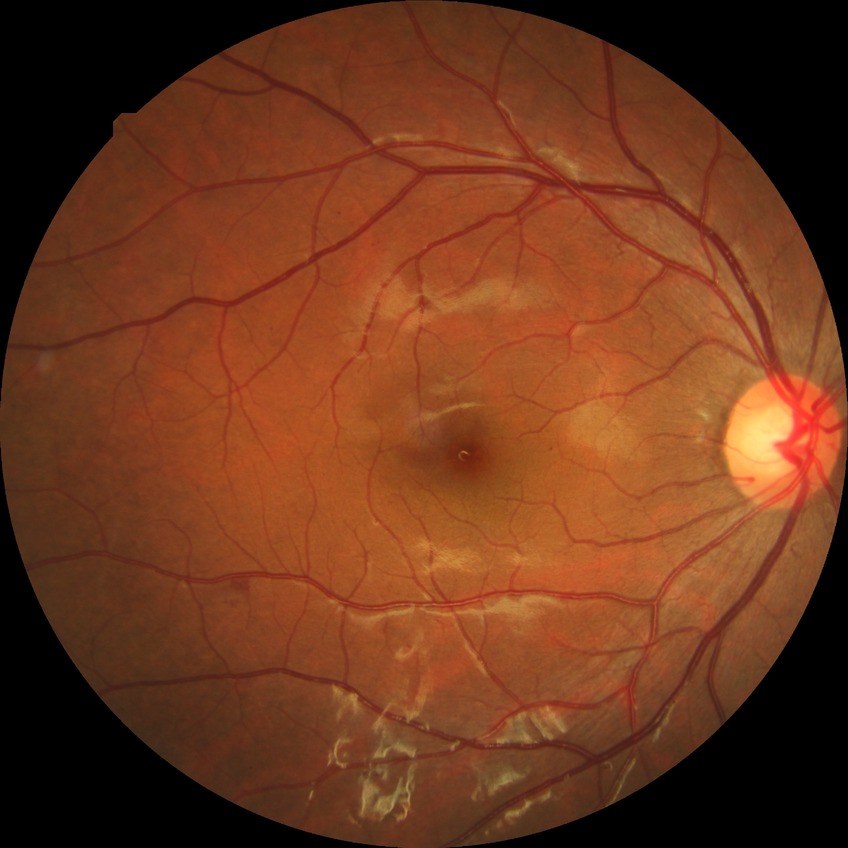 Diabetic retinopathy (DR) is SDR (simple diabetic retinopathy).